Non-mydriatic fundus camera; retinal fundus photograph; camera: Nidek AFC-330 — 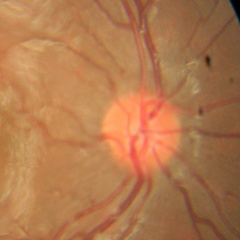
Demonstrates no signs of glaucoma.